848 x 848 pixels:
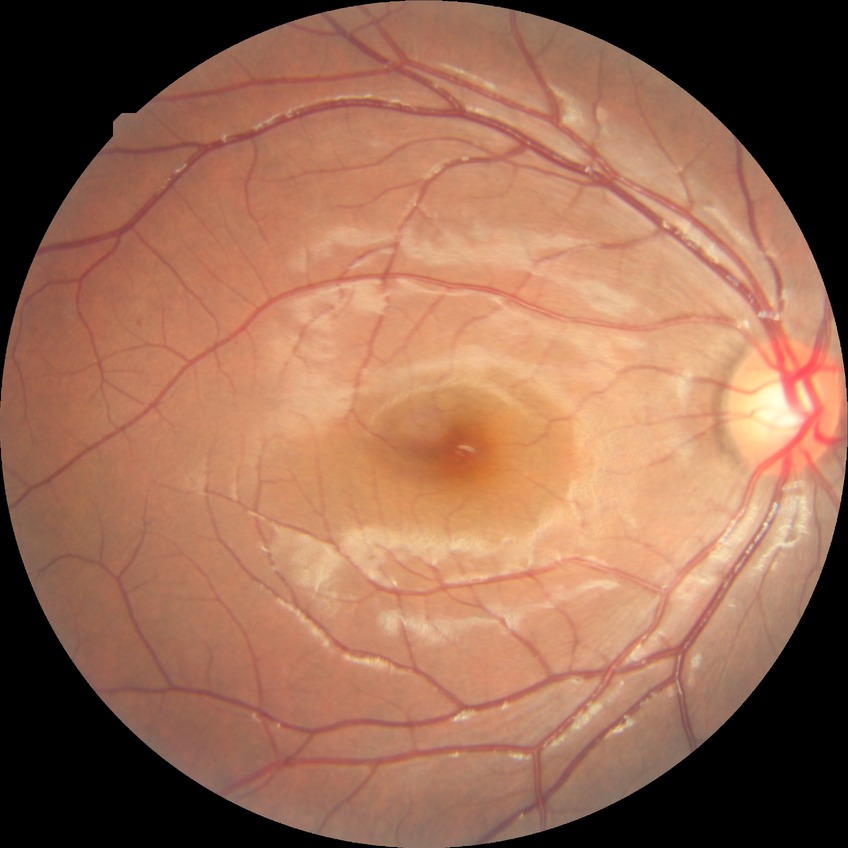 davis_grade: no diabetic retinopathy